Acquired with a NIDEK AFC-230
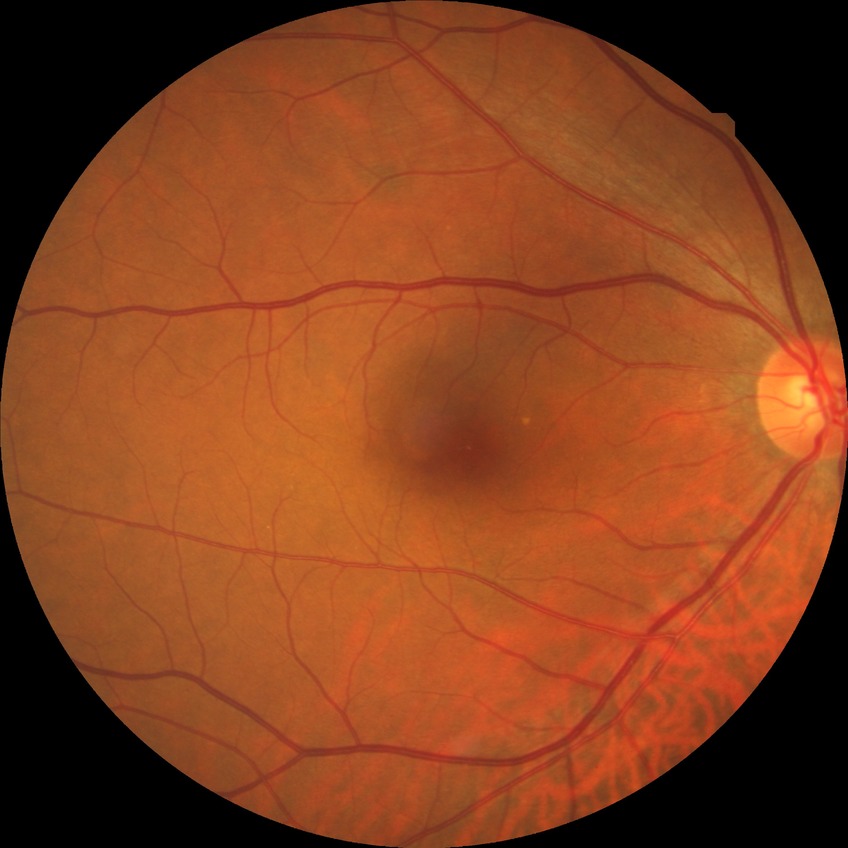 Diabetic retinopathy (DR): SDR (simple diabetic retinopathy).